2352x1568px. CFP: 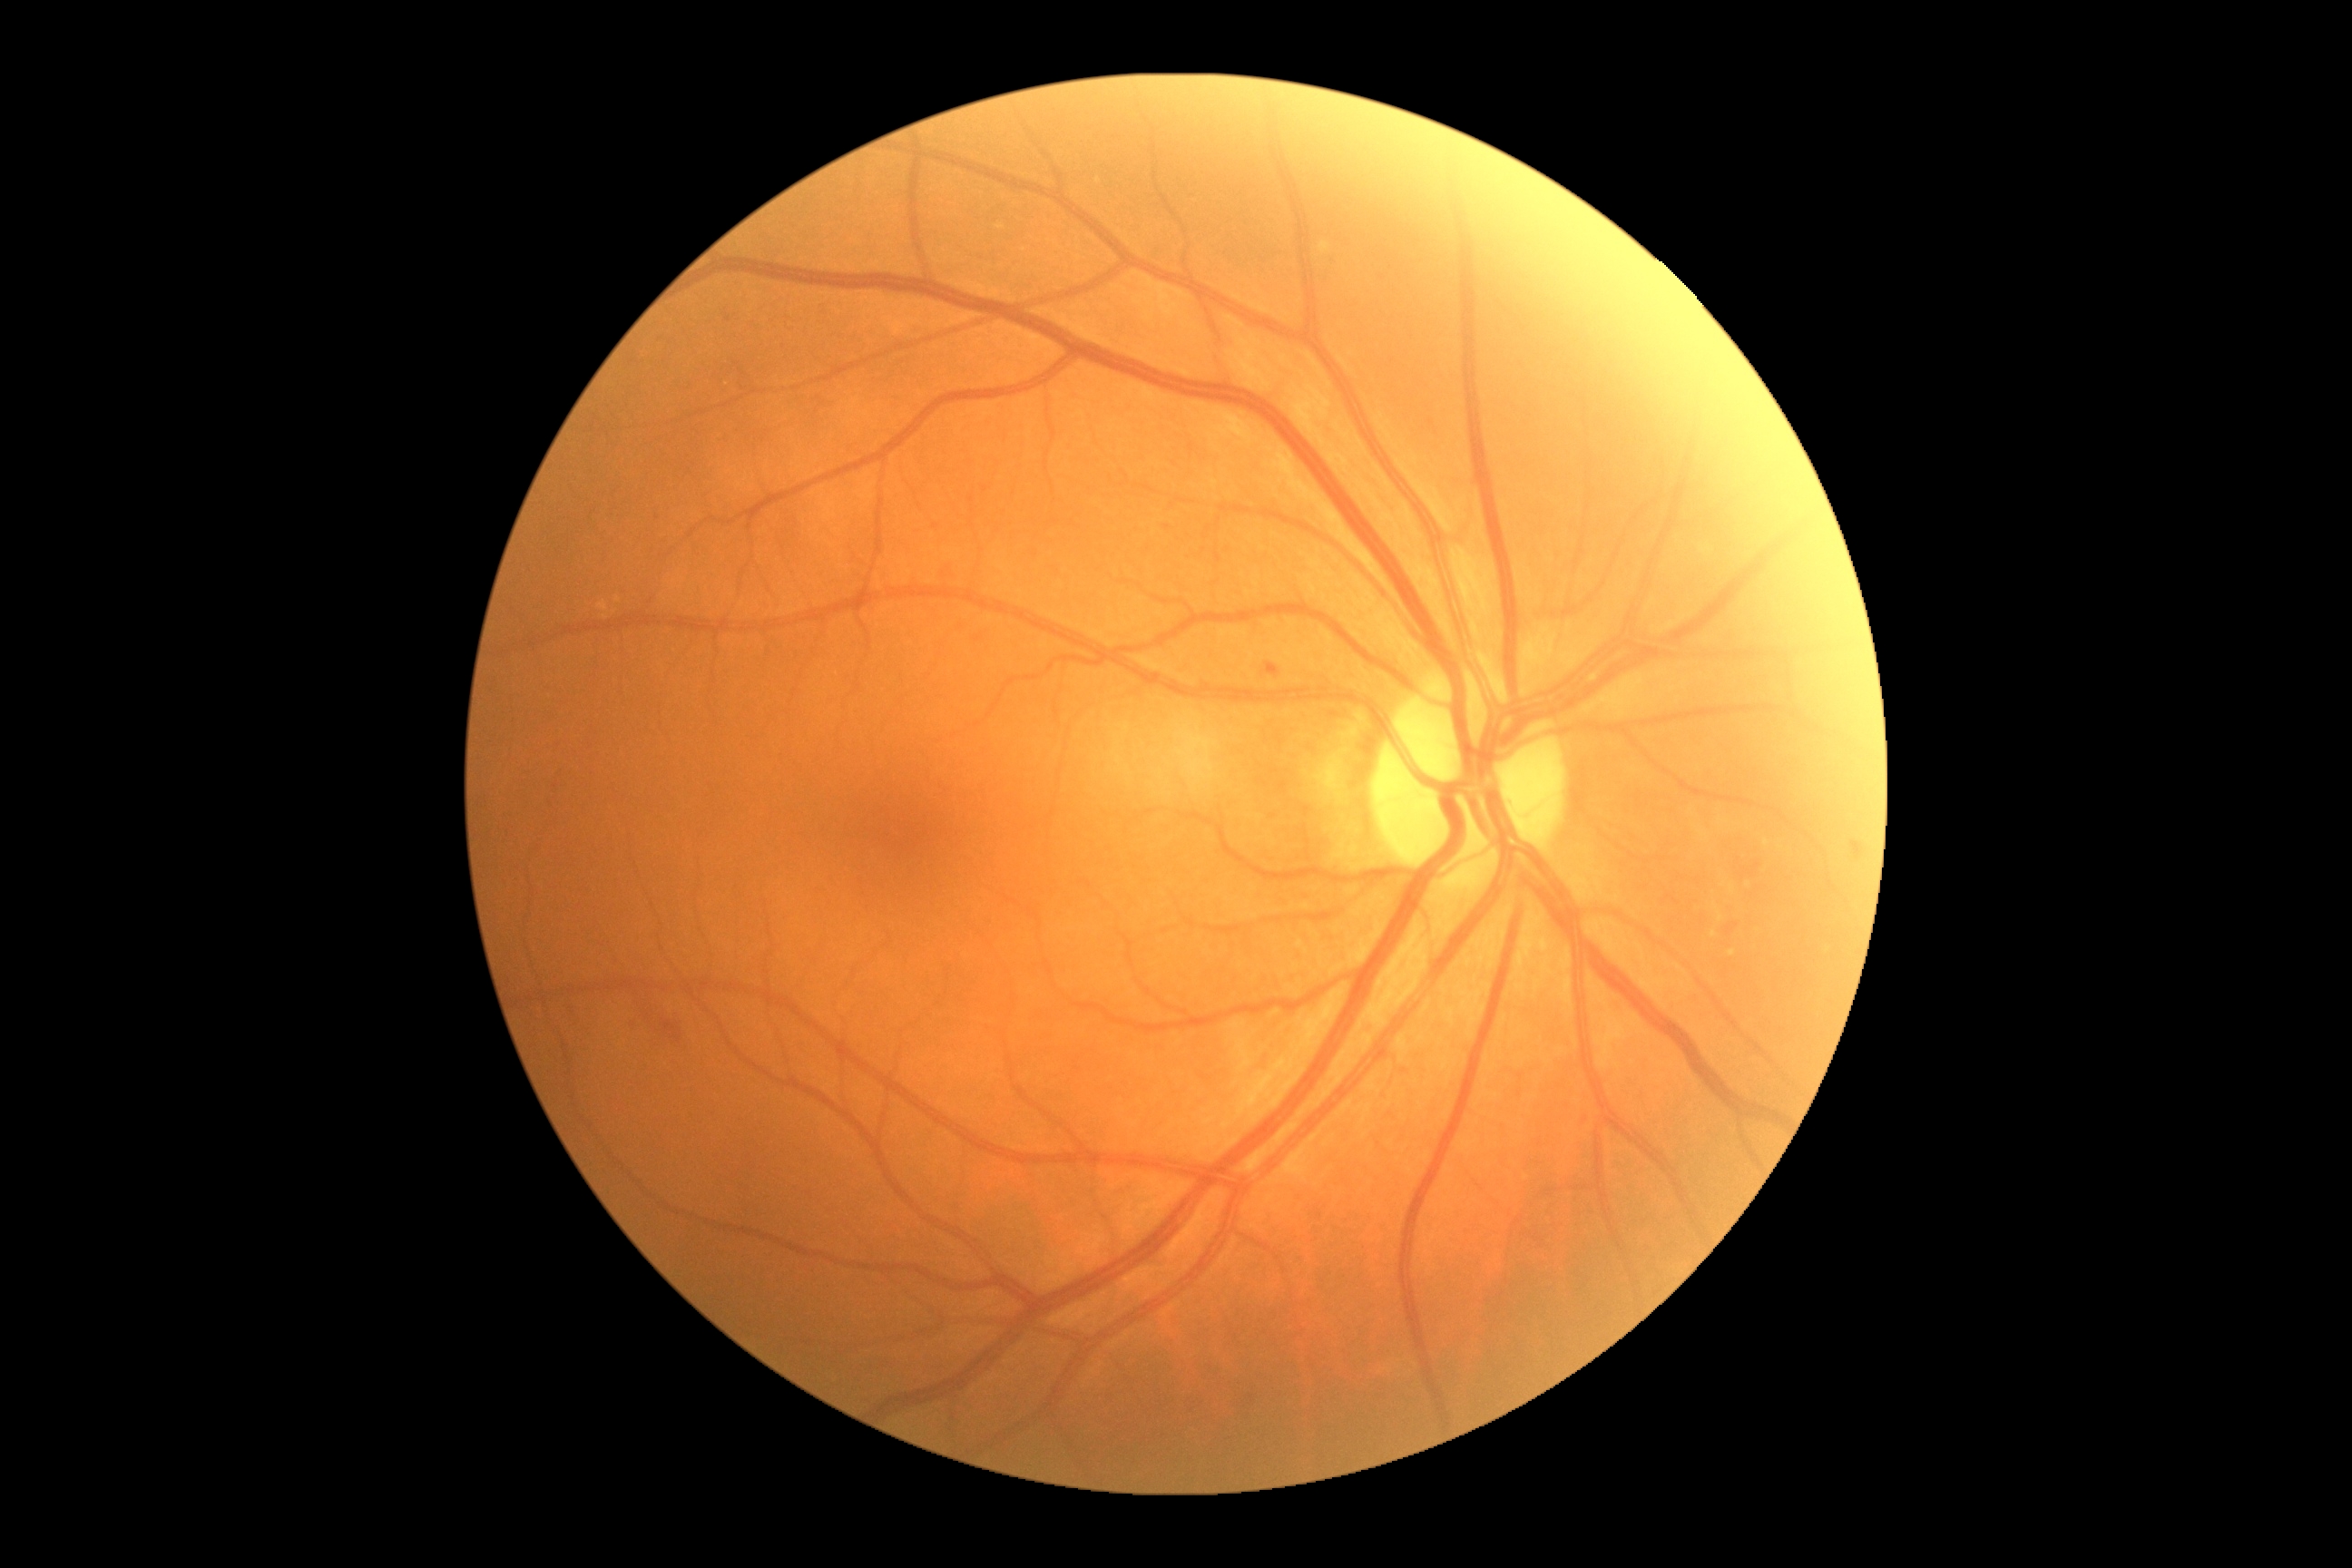 Retinopathy grade is 2.